Image size 2352x1568
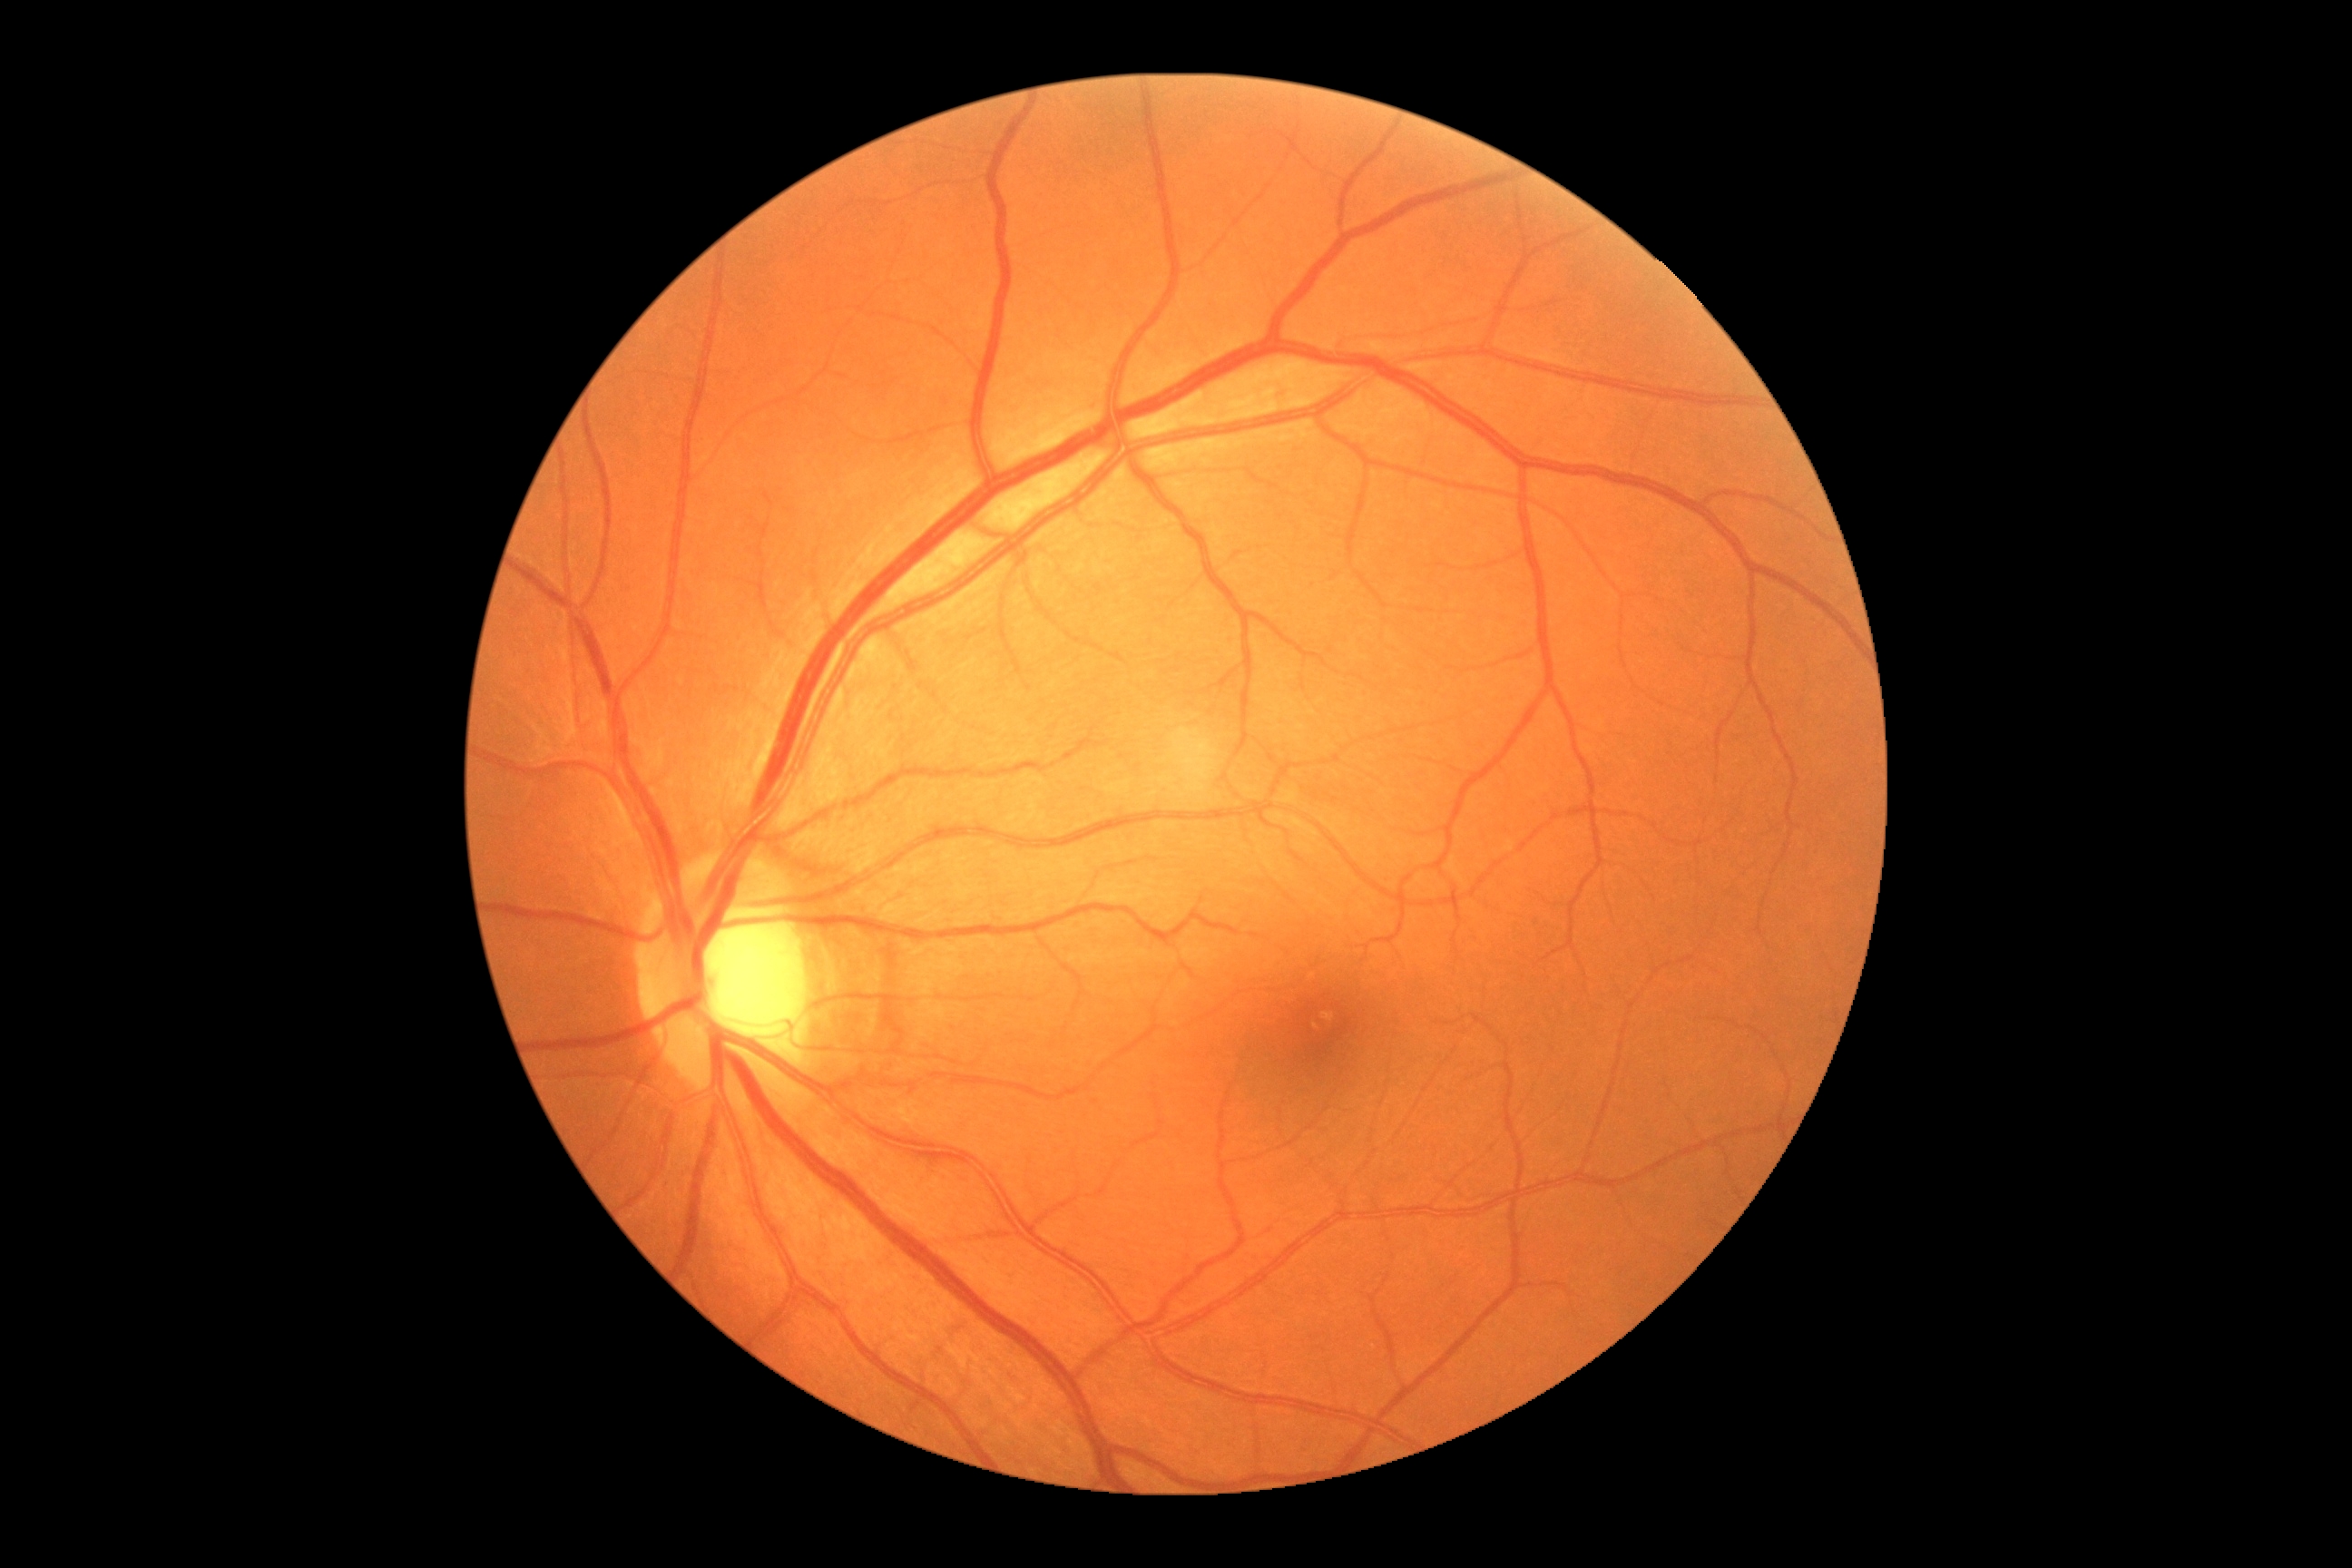

dr_grade: grade 0 (no apparent retinopathy)
dr_impression: no apparent DR